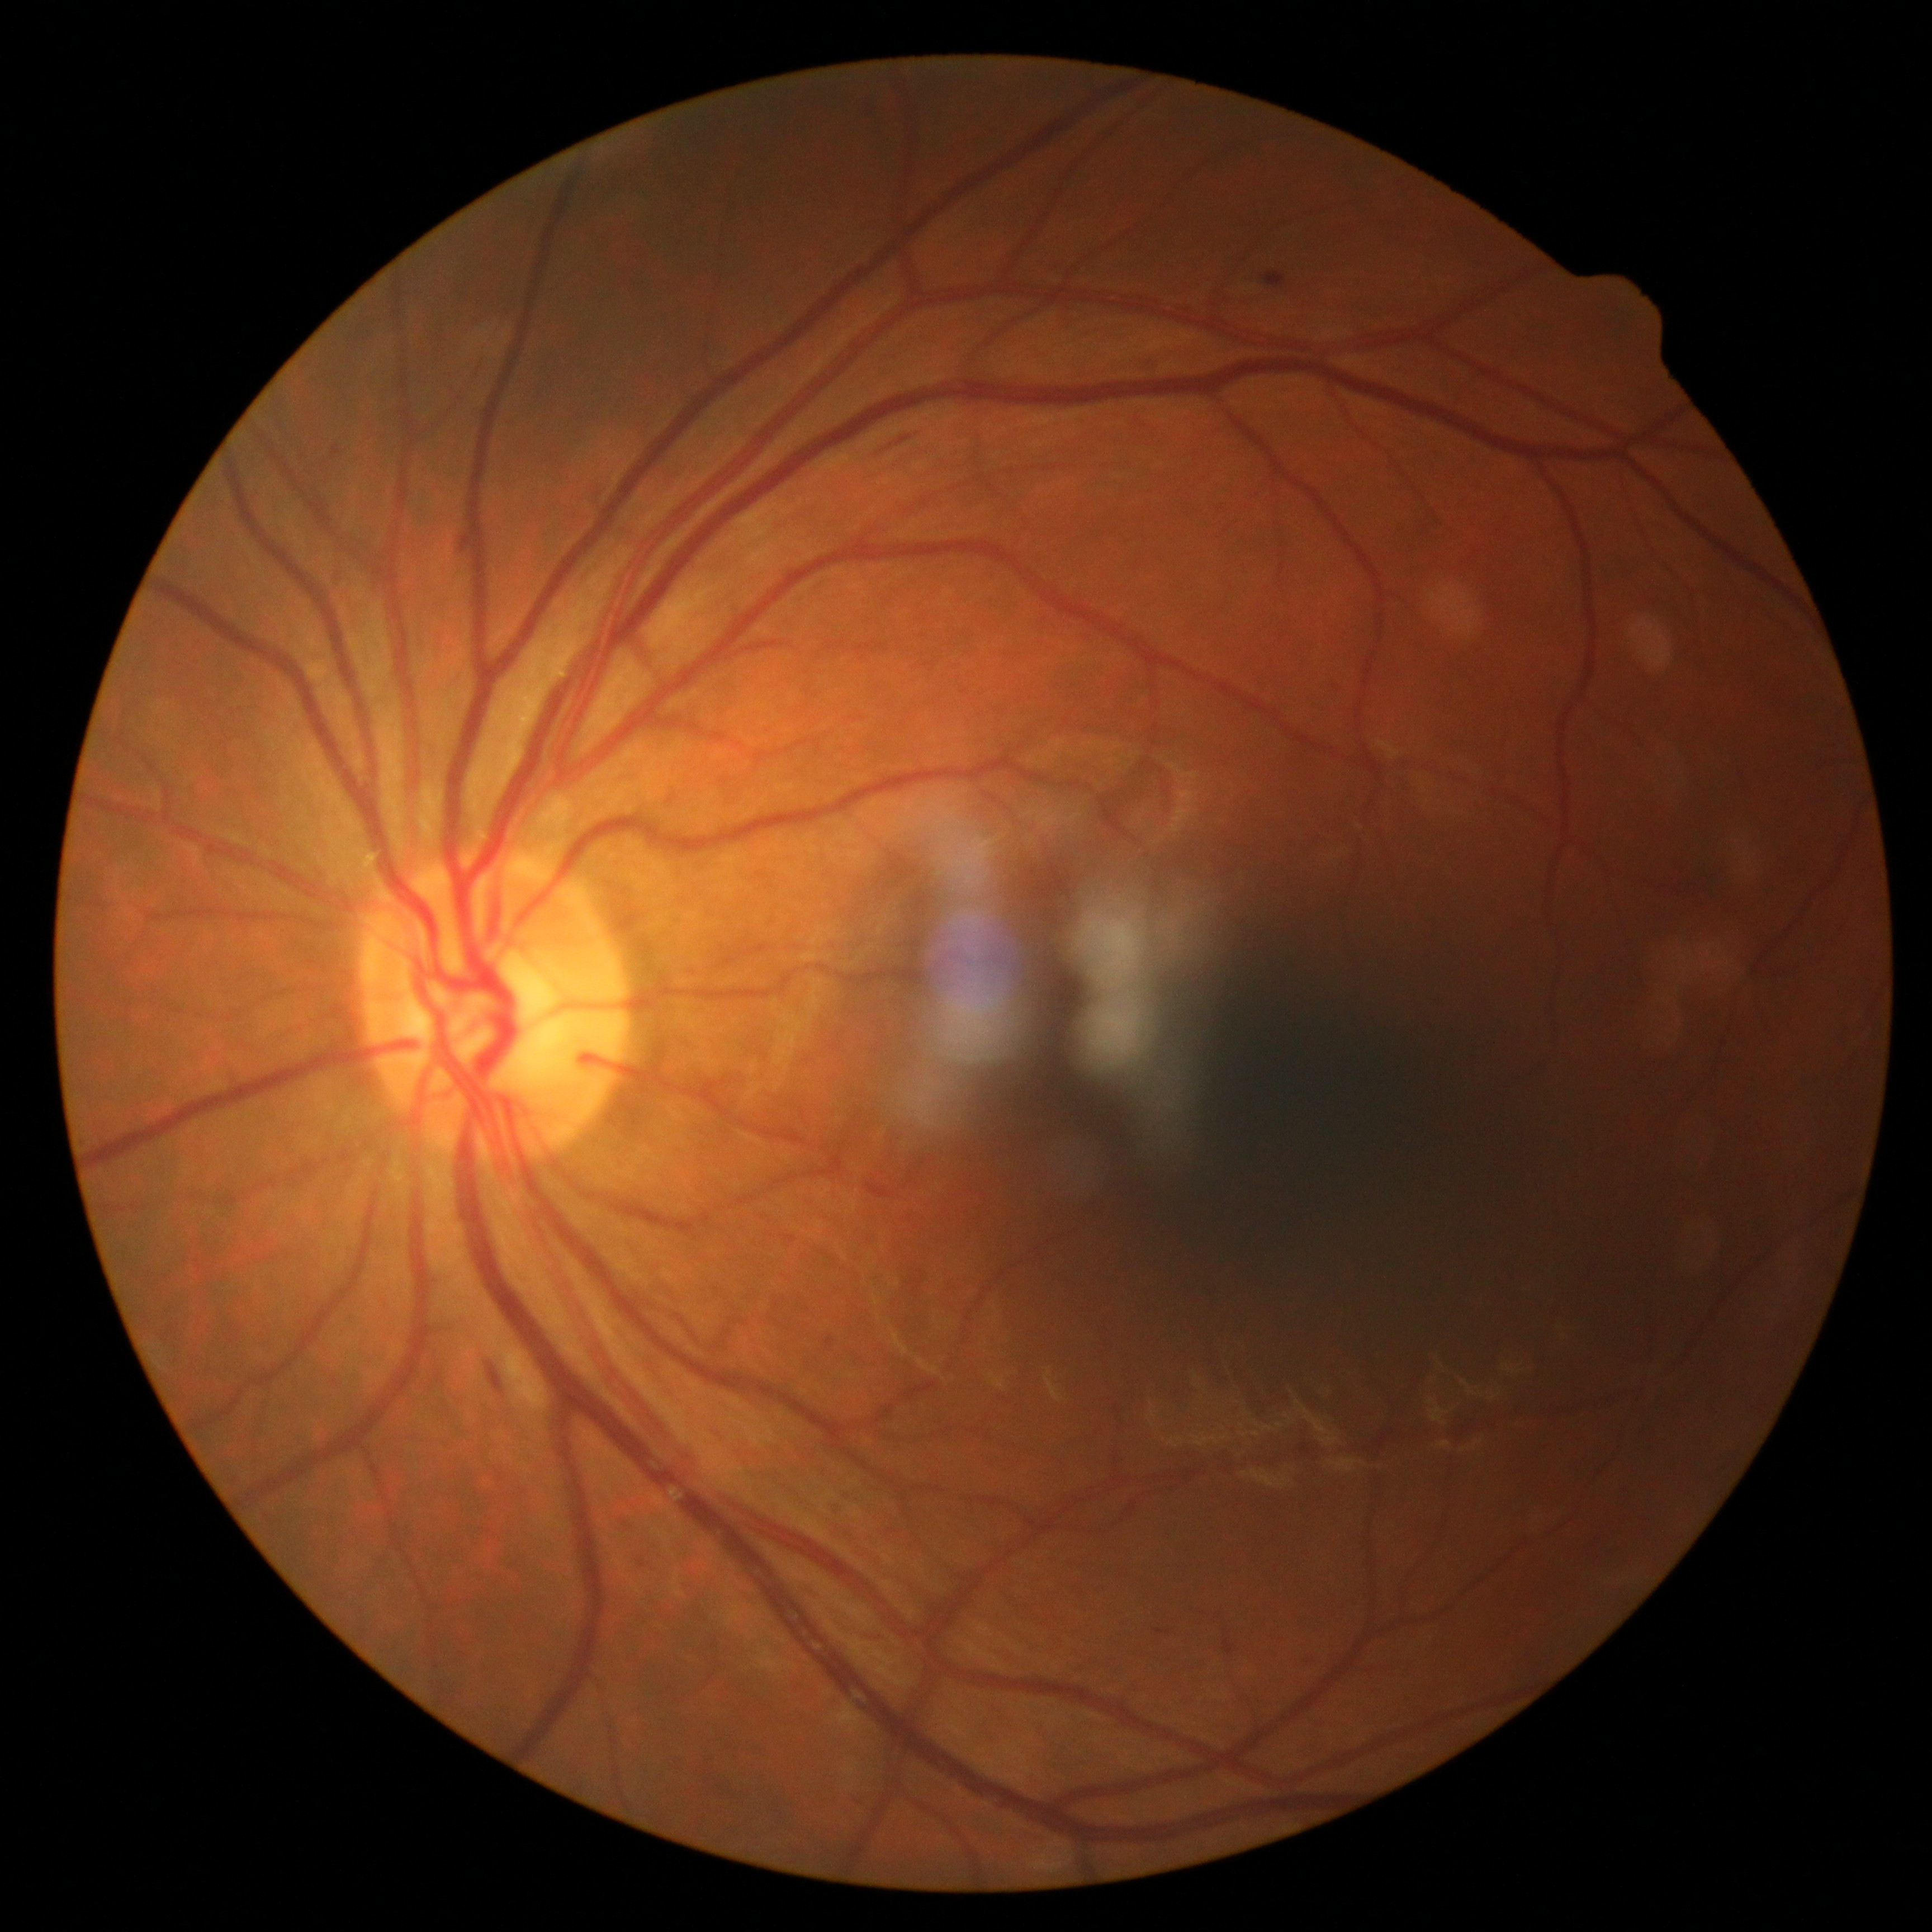
DR grade is 2 (moderate NPDR).